Posterior pole color fundus photograph. Without pupil dilation. 45 degree fundus photograph. 848 x 848 pixels.
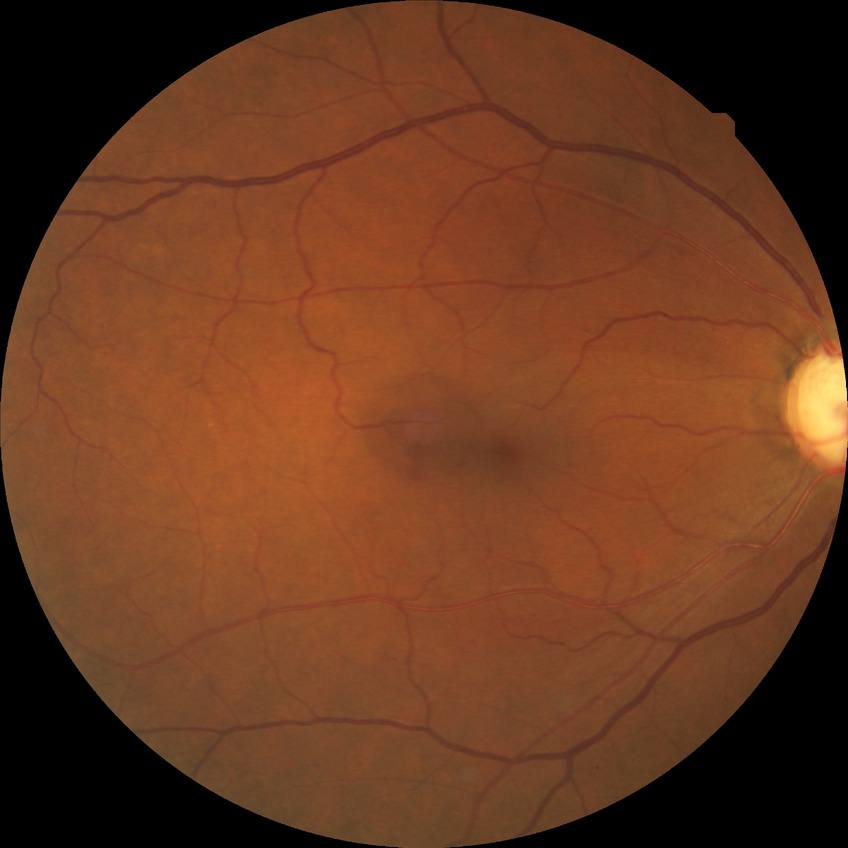 Diabetic retinopathy (DR) is no diabetic retinopathy (NDR).